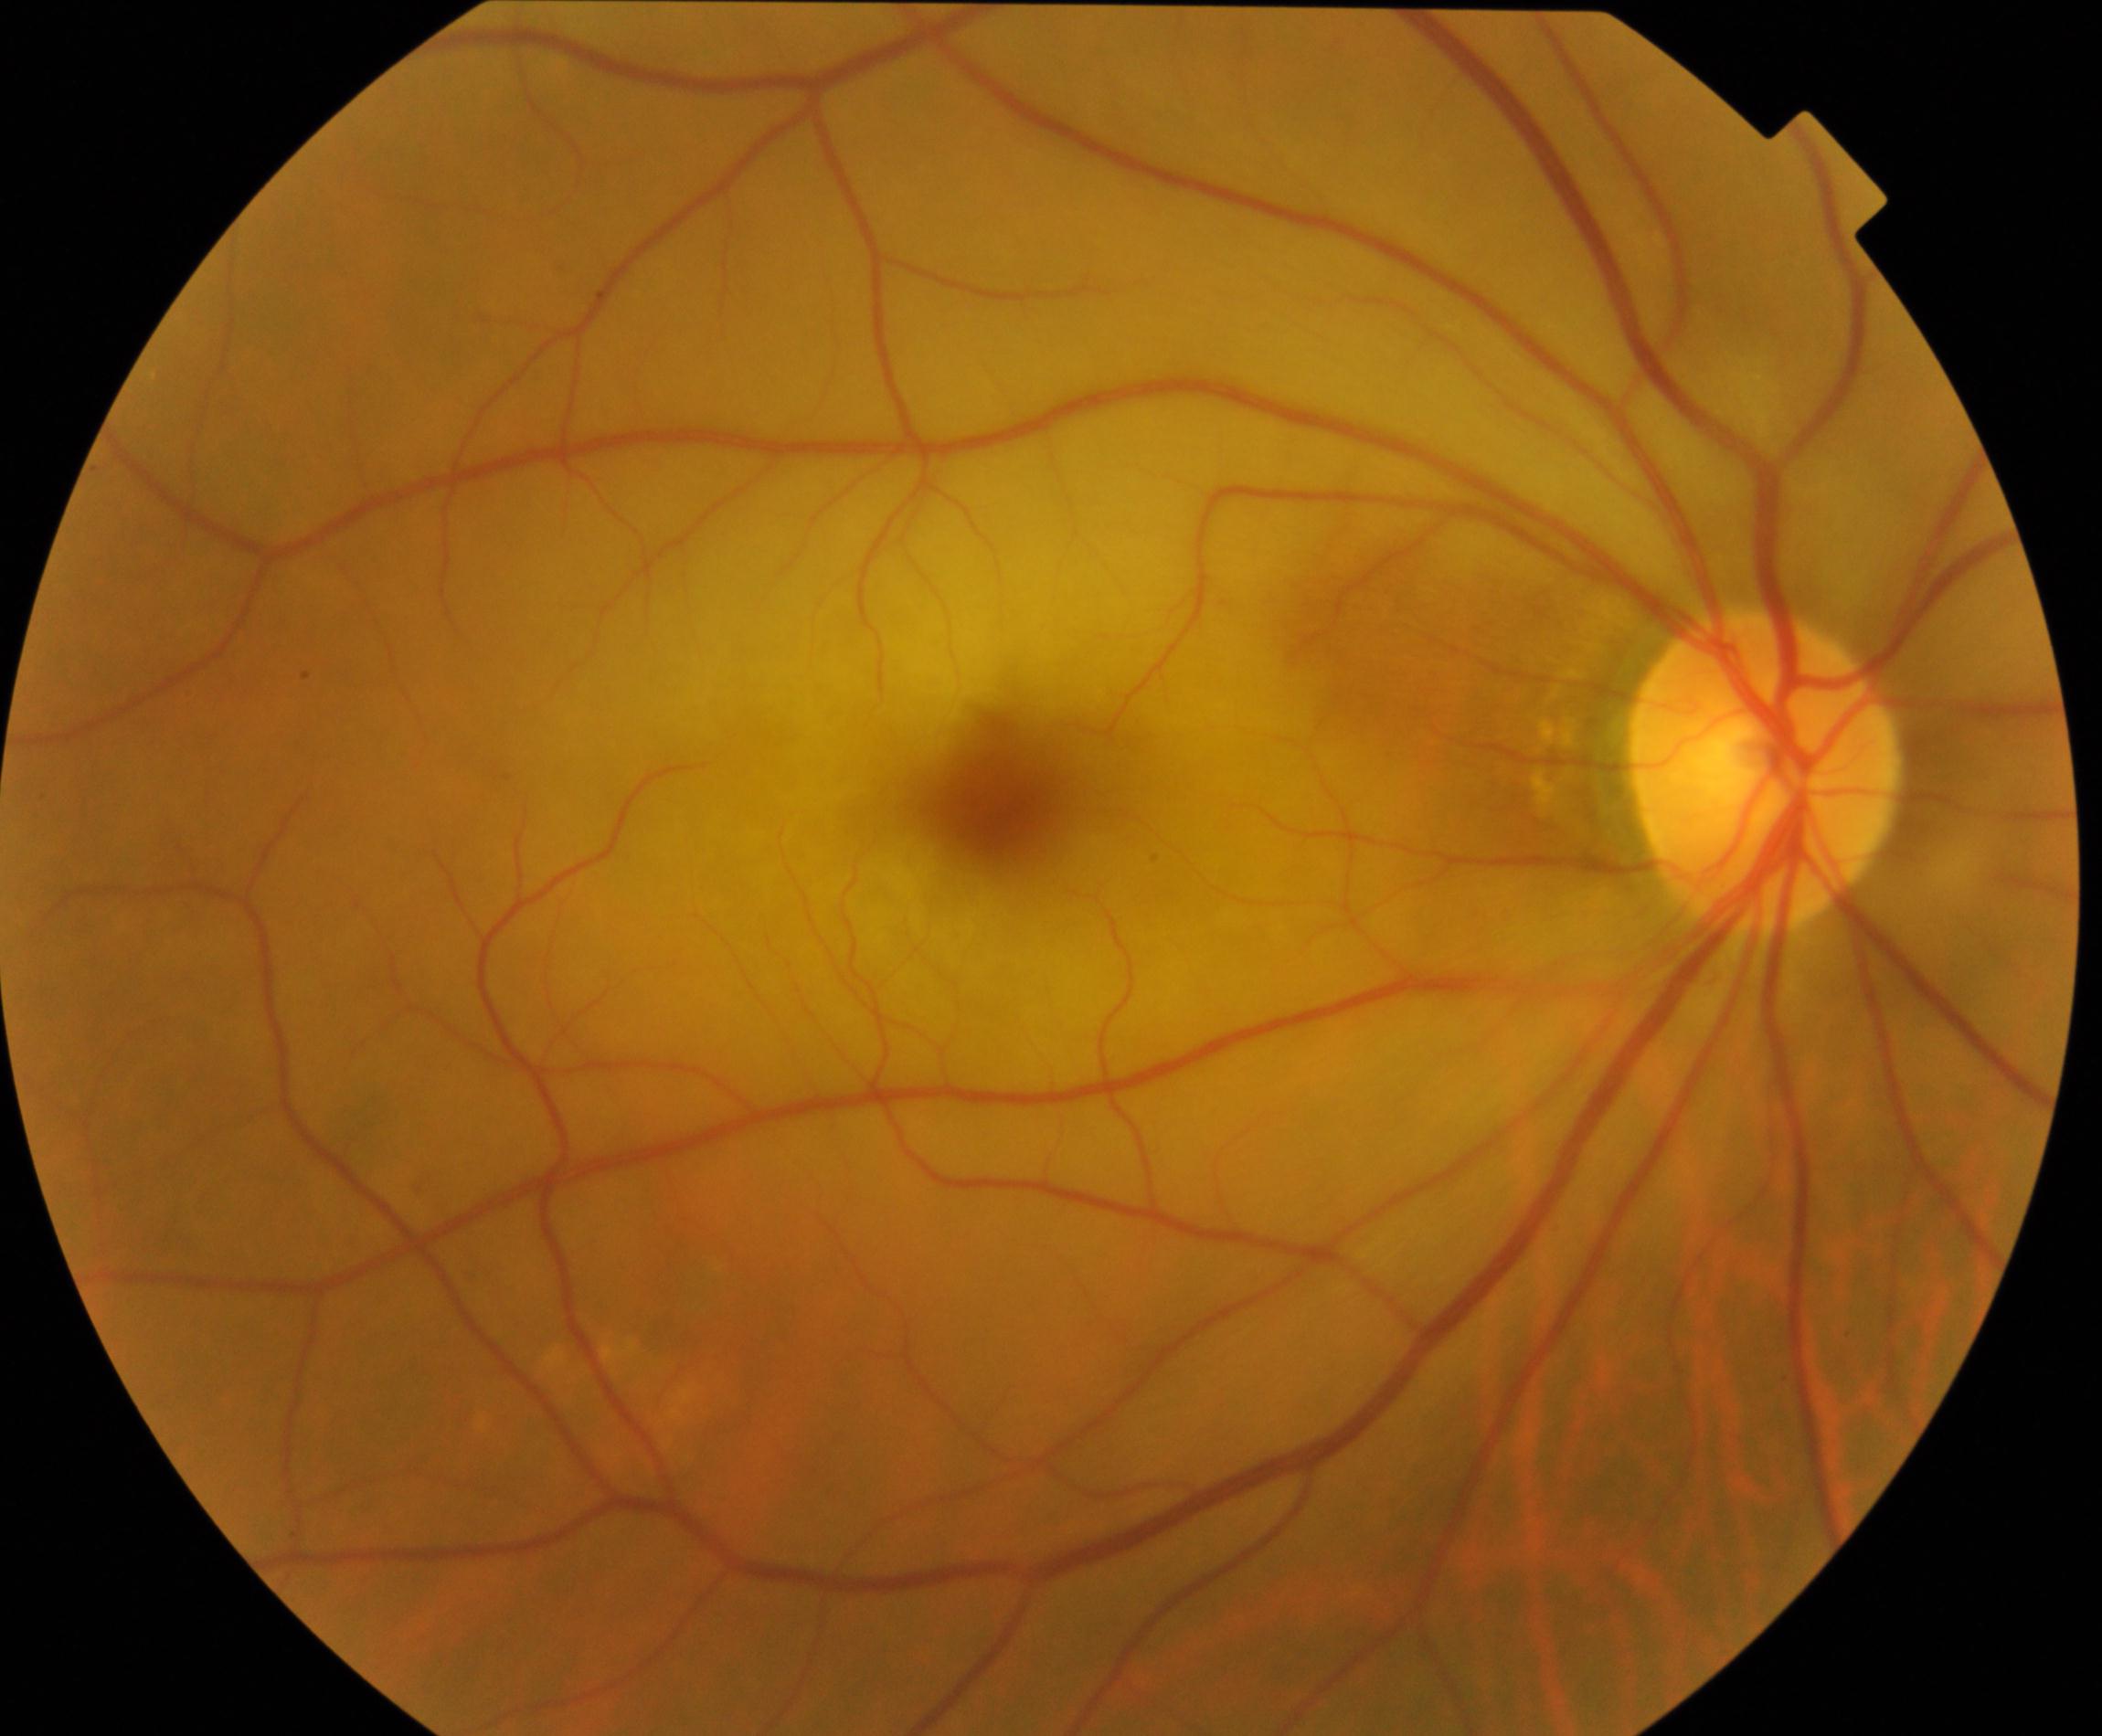
Fundus appearance consistent with retinal artery occlusion (RAO).